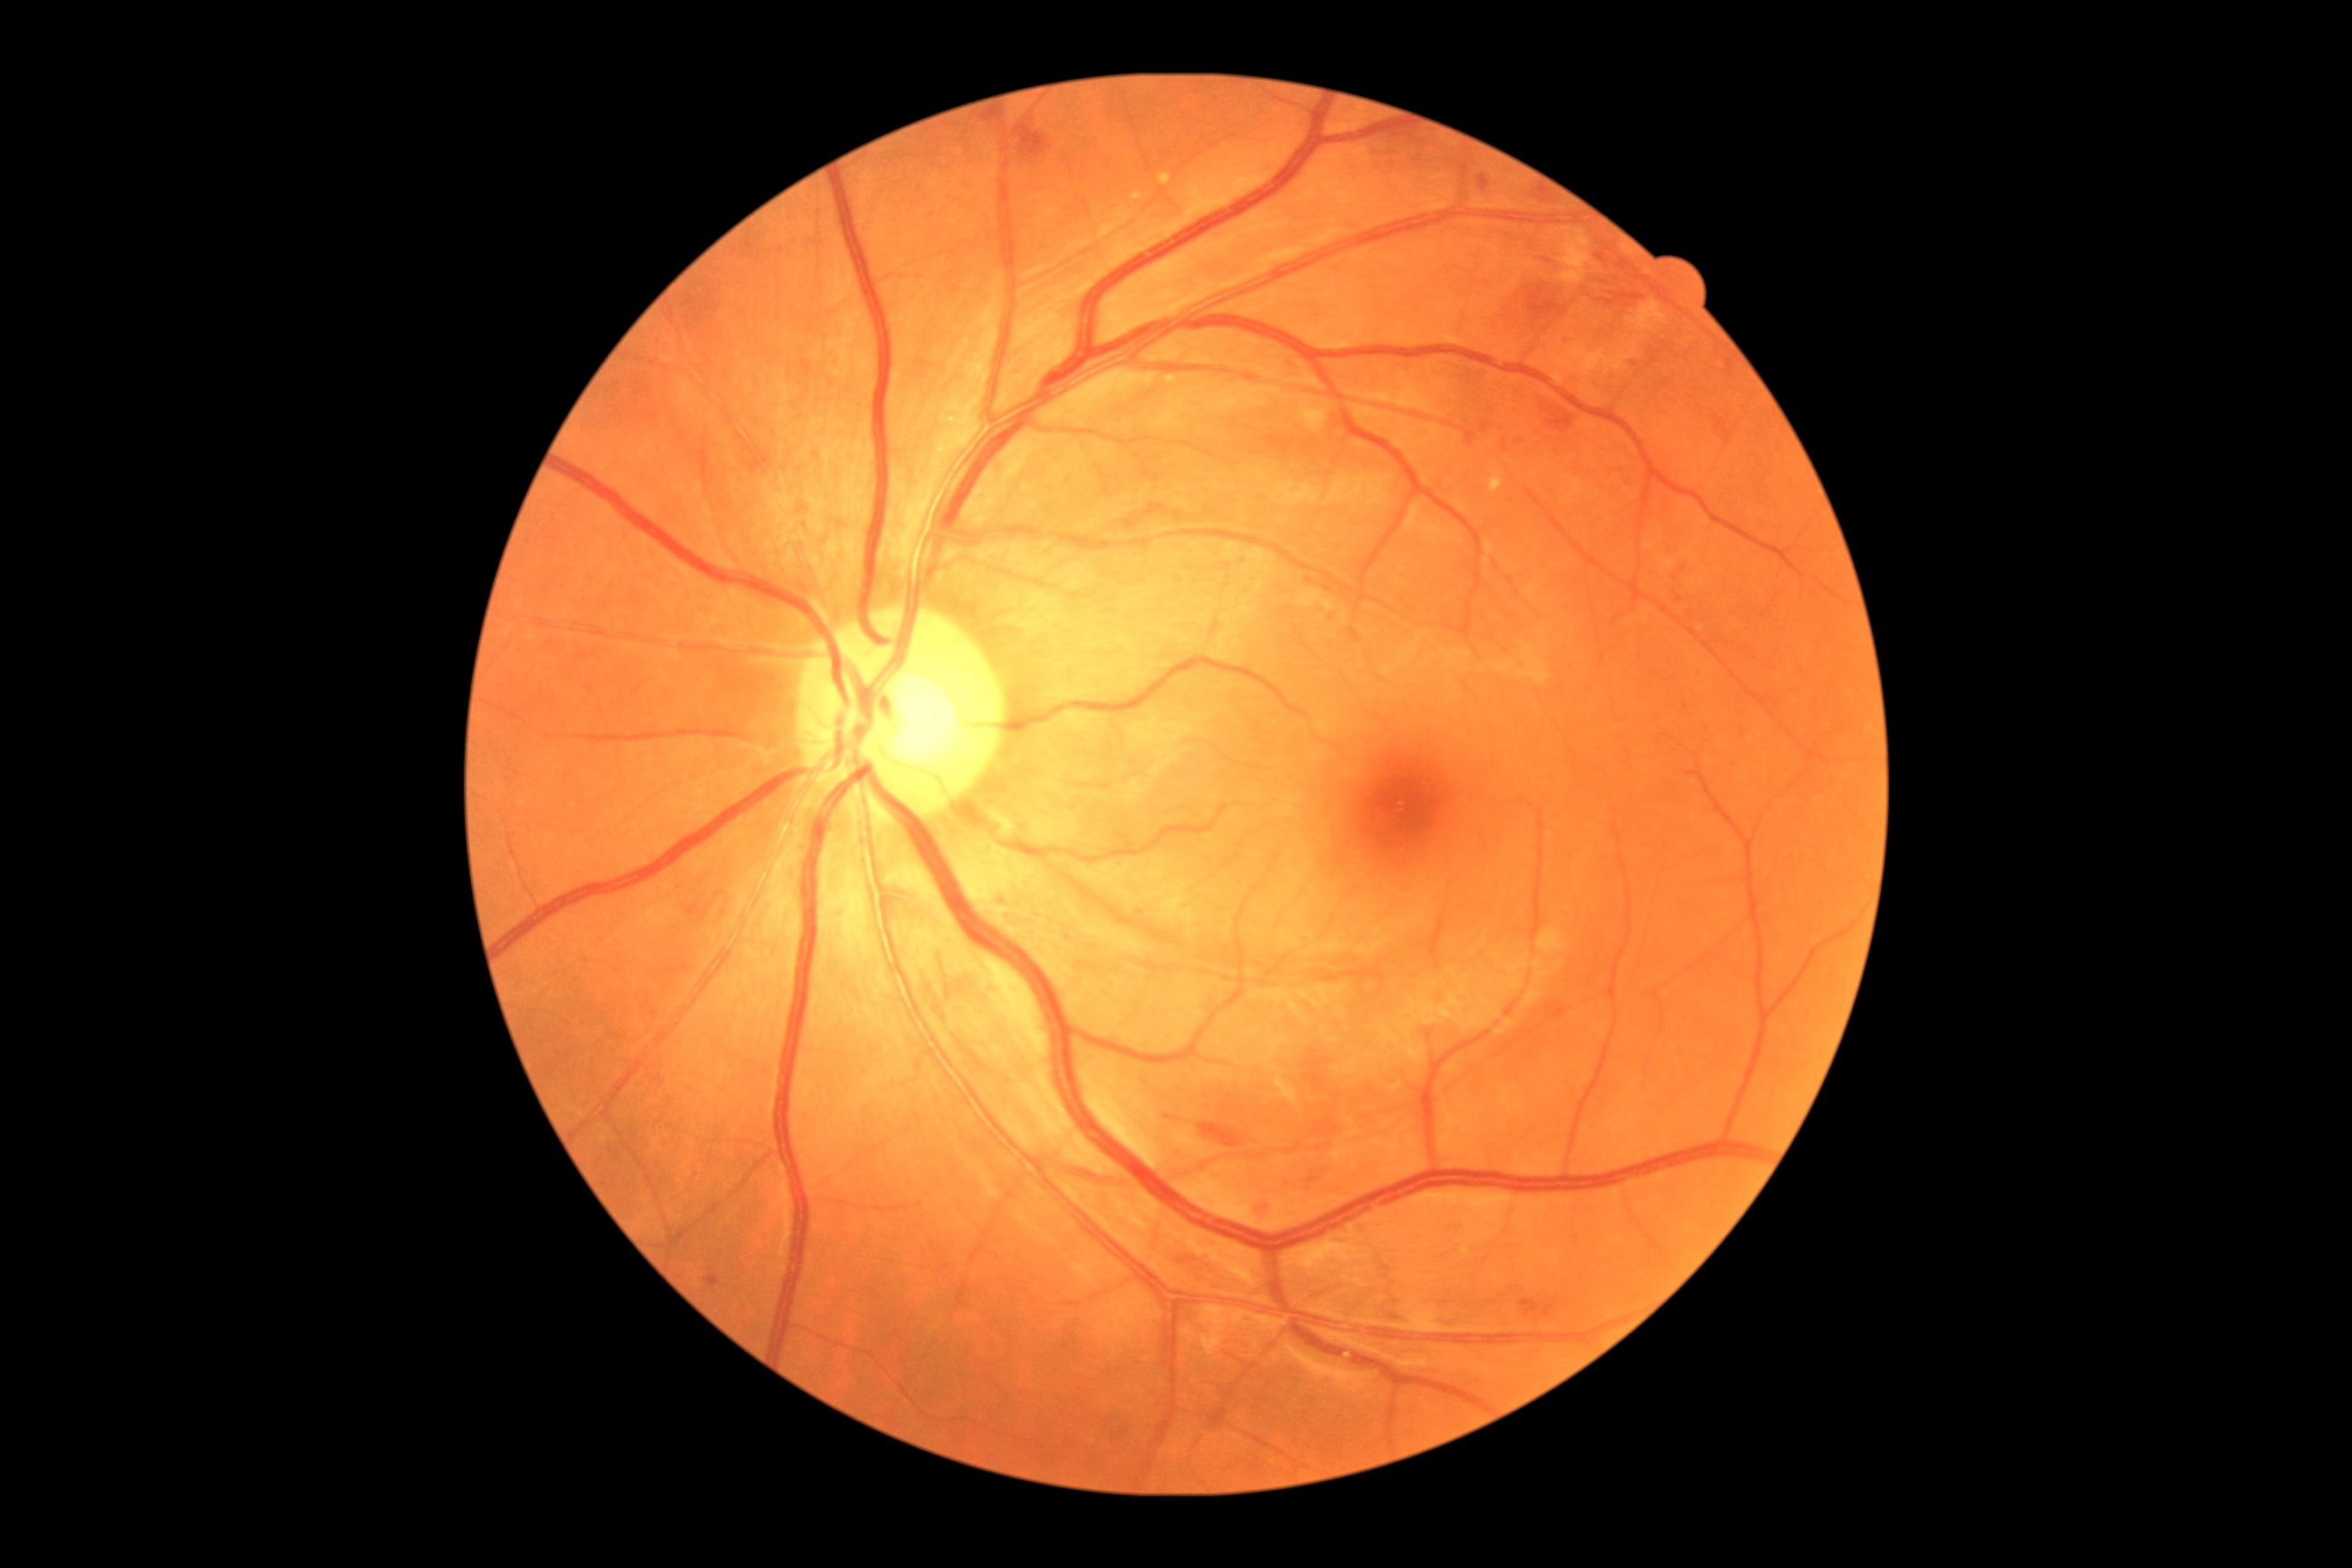

diabetic retinopathy severity=grade 2.